2048x1536.
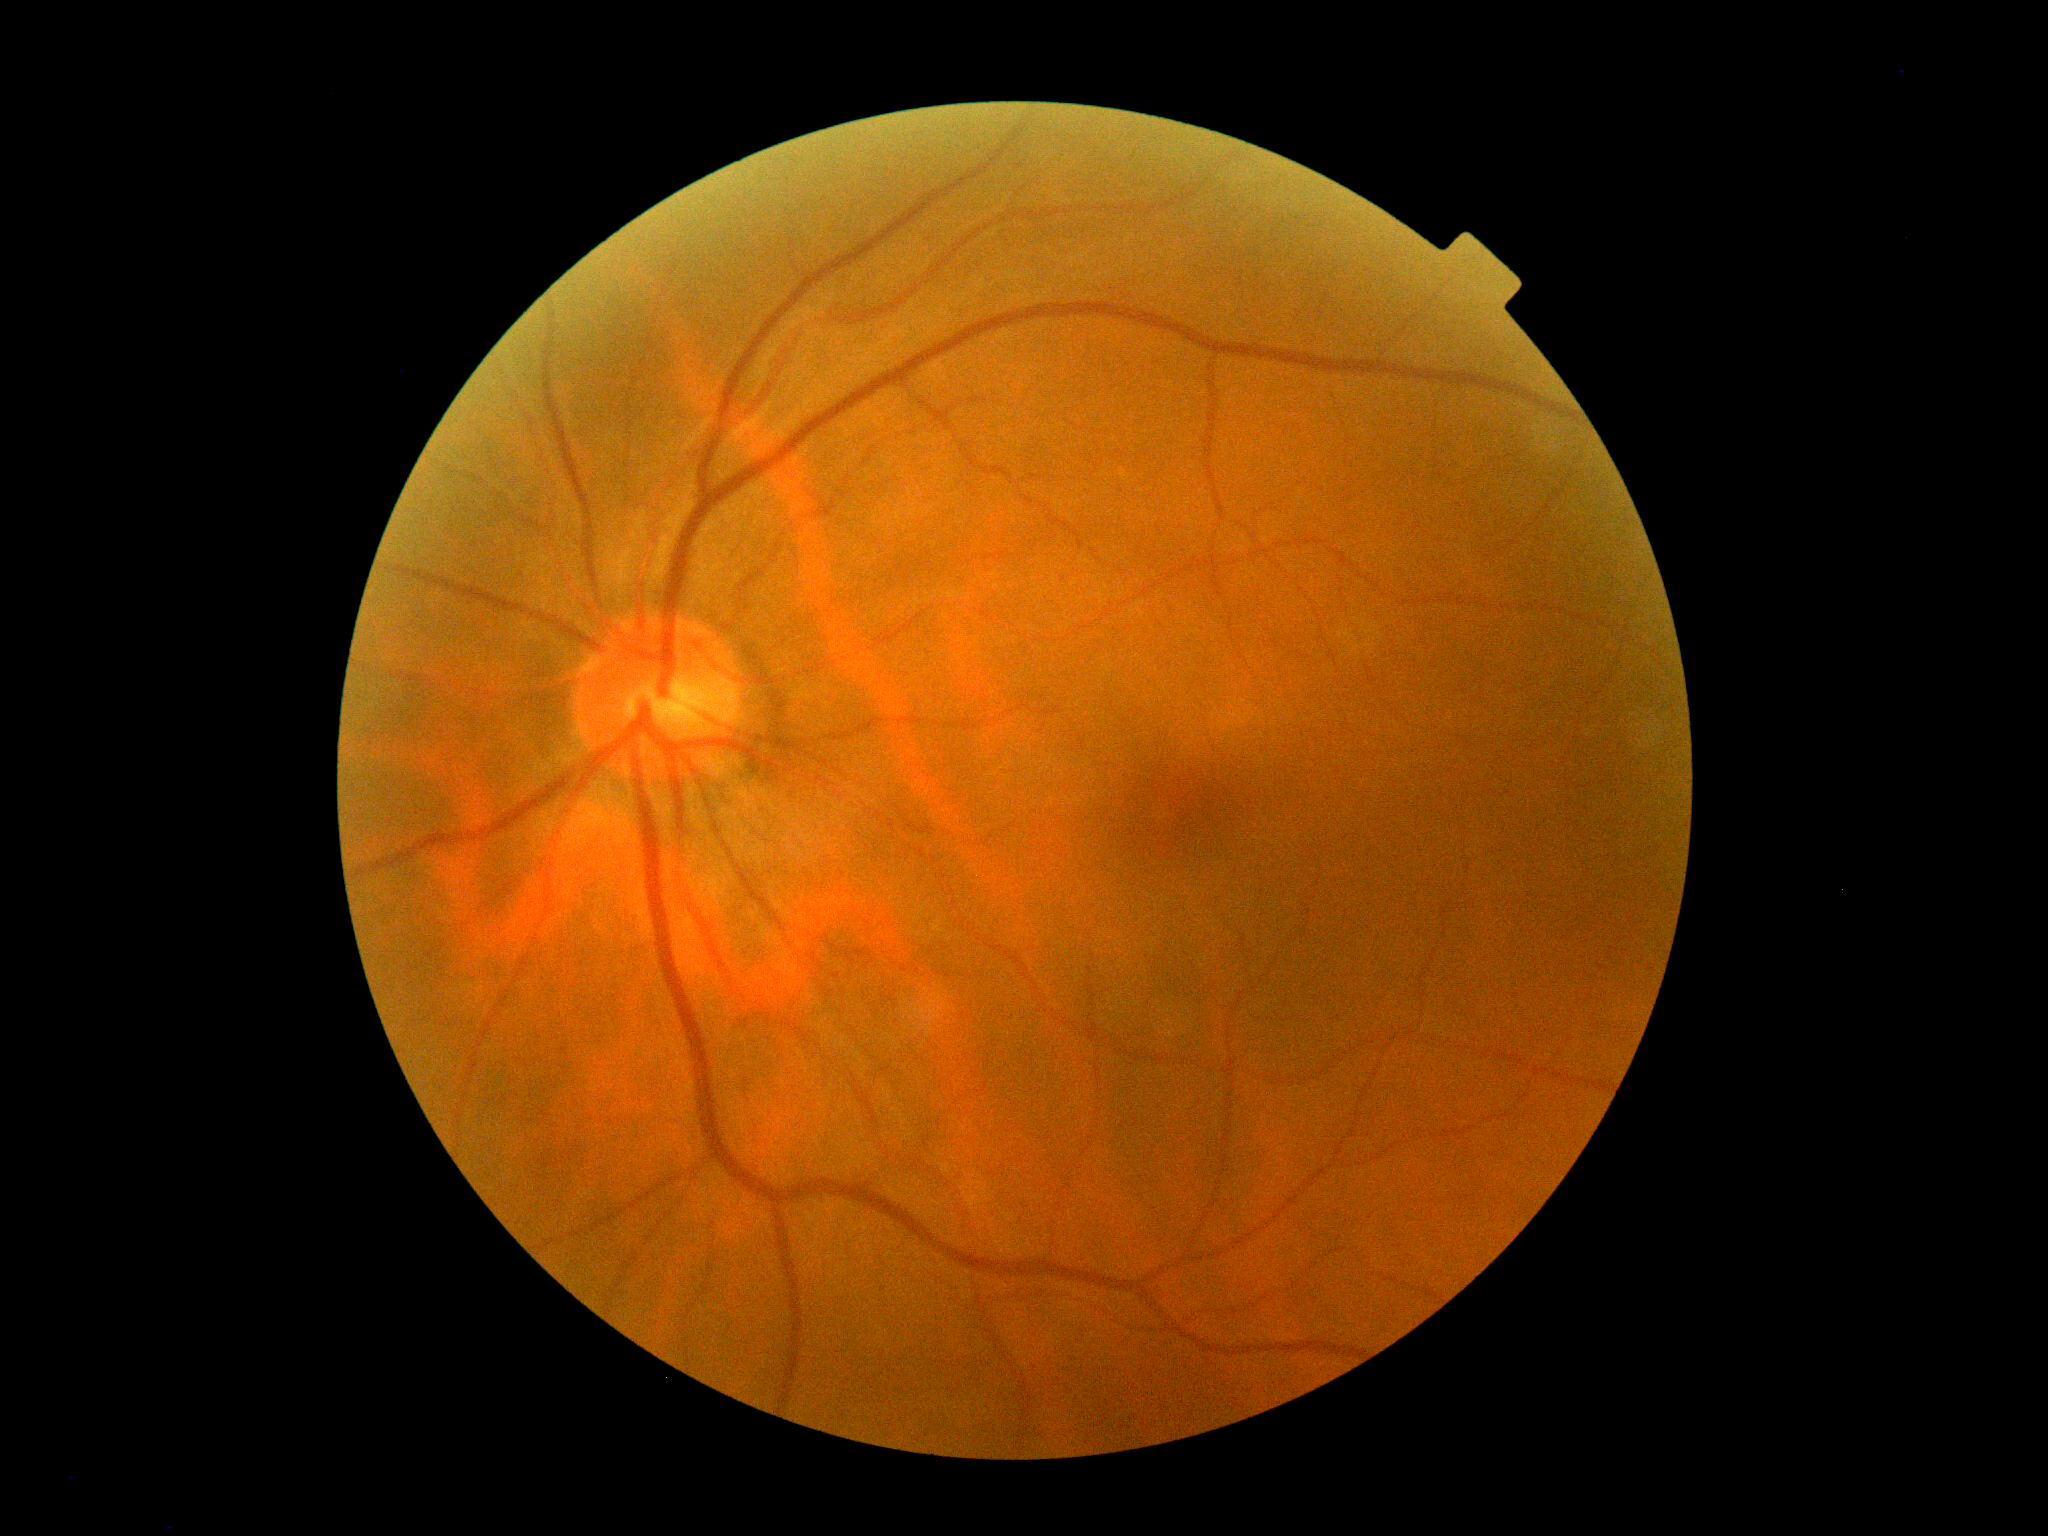
dr_impression: no DR findings
dr_grade: grade 0